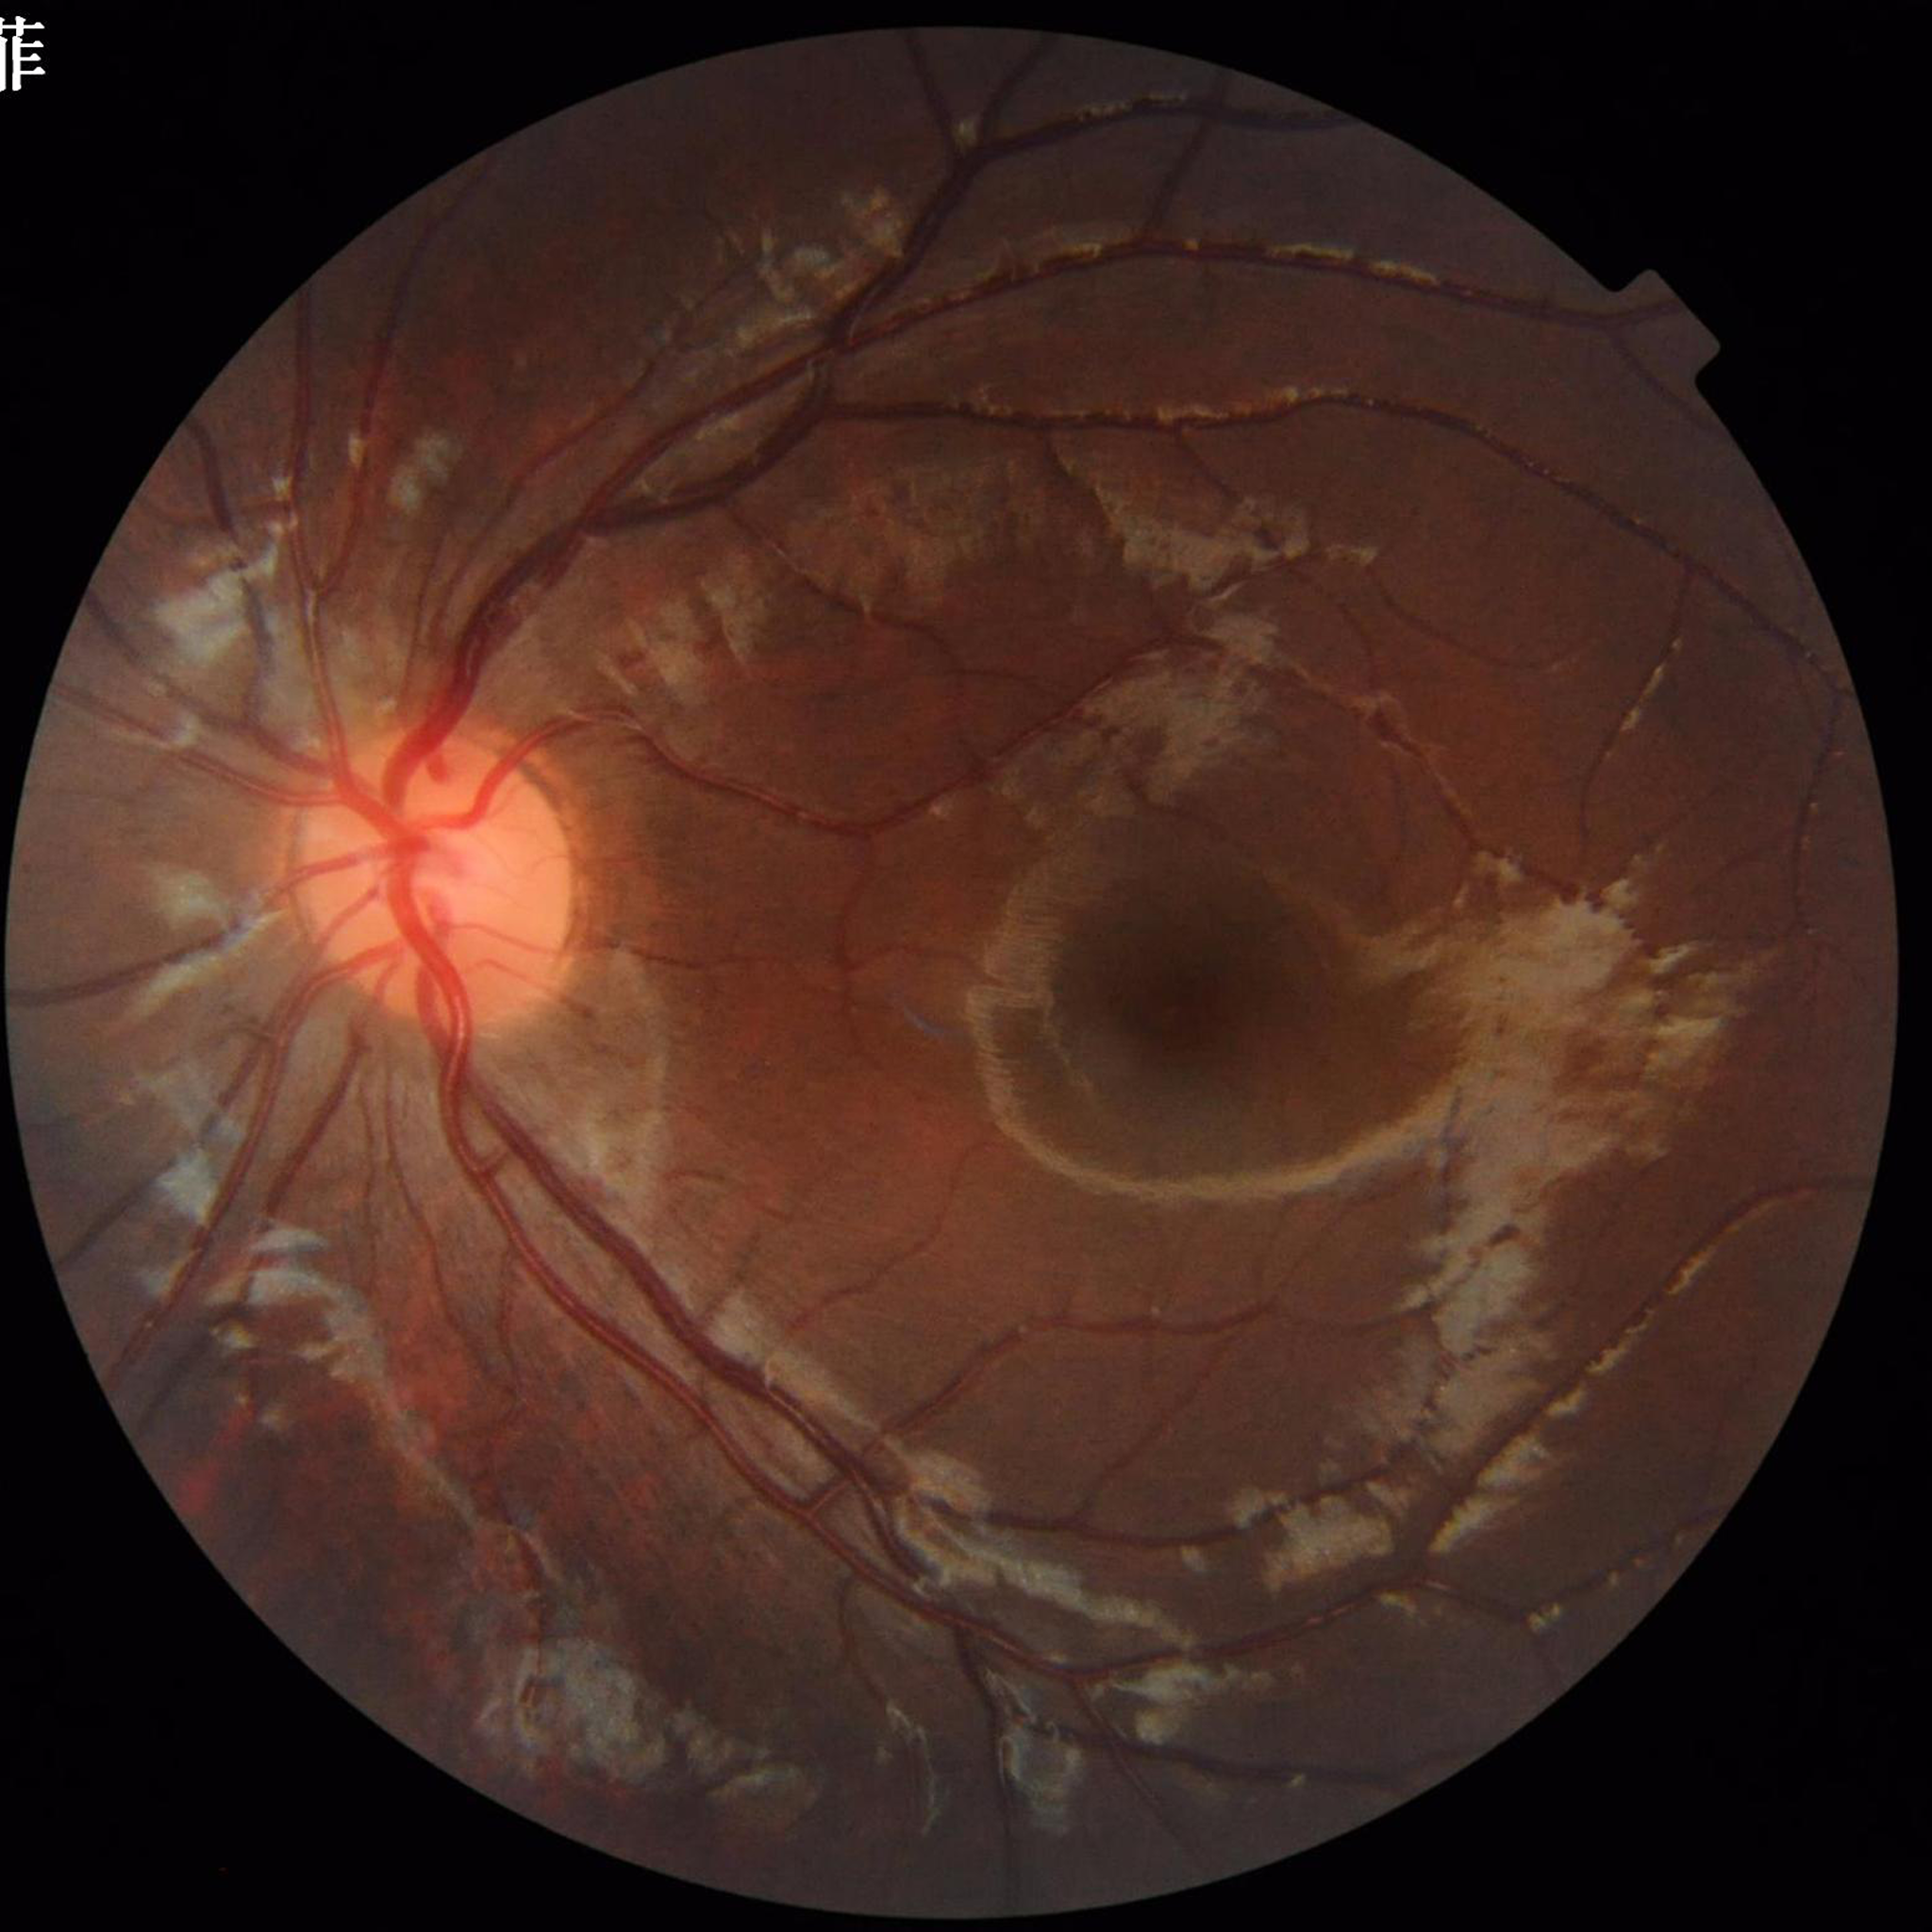 {
  "diagnosis": "no AMD, DR, or glaucoma",
  "image_quality": "good"
}